Posterior pole color fundus photograph, DR severity per modified Davis staging — 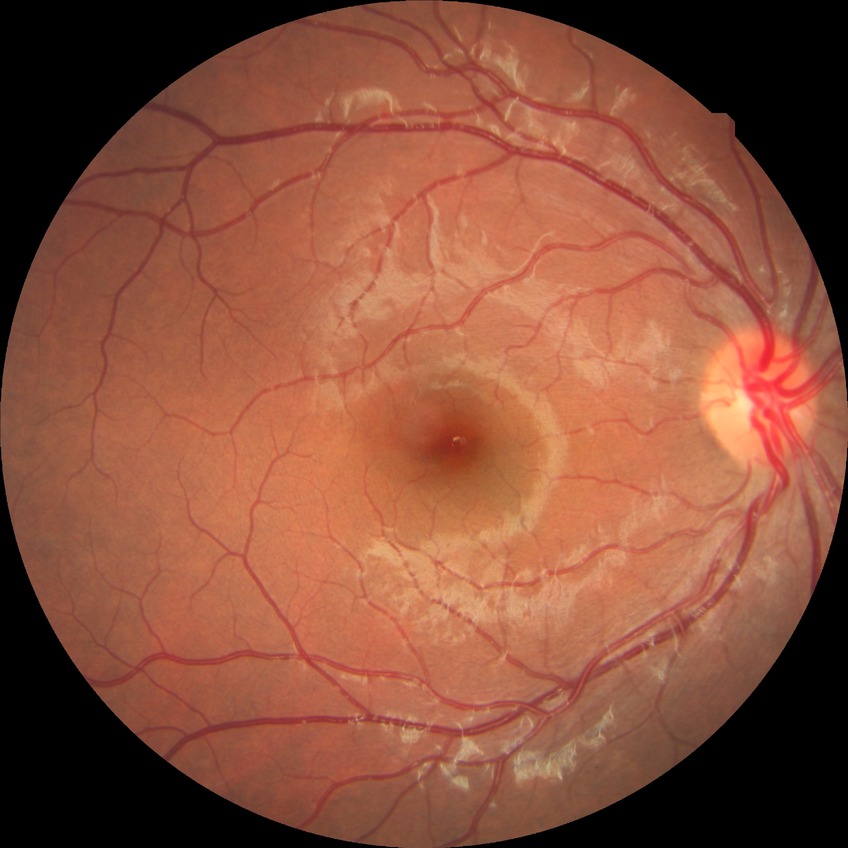
diabetic retinopathy (DR)=no diabetic retinopathy (NDR).